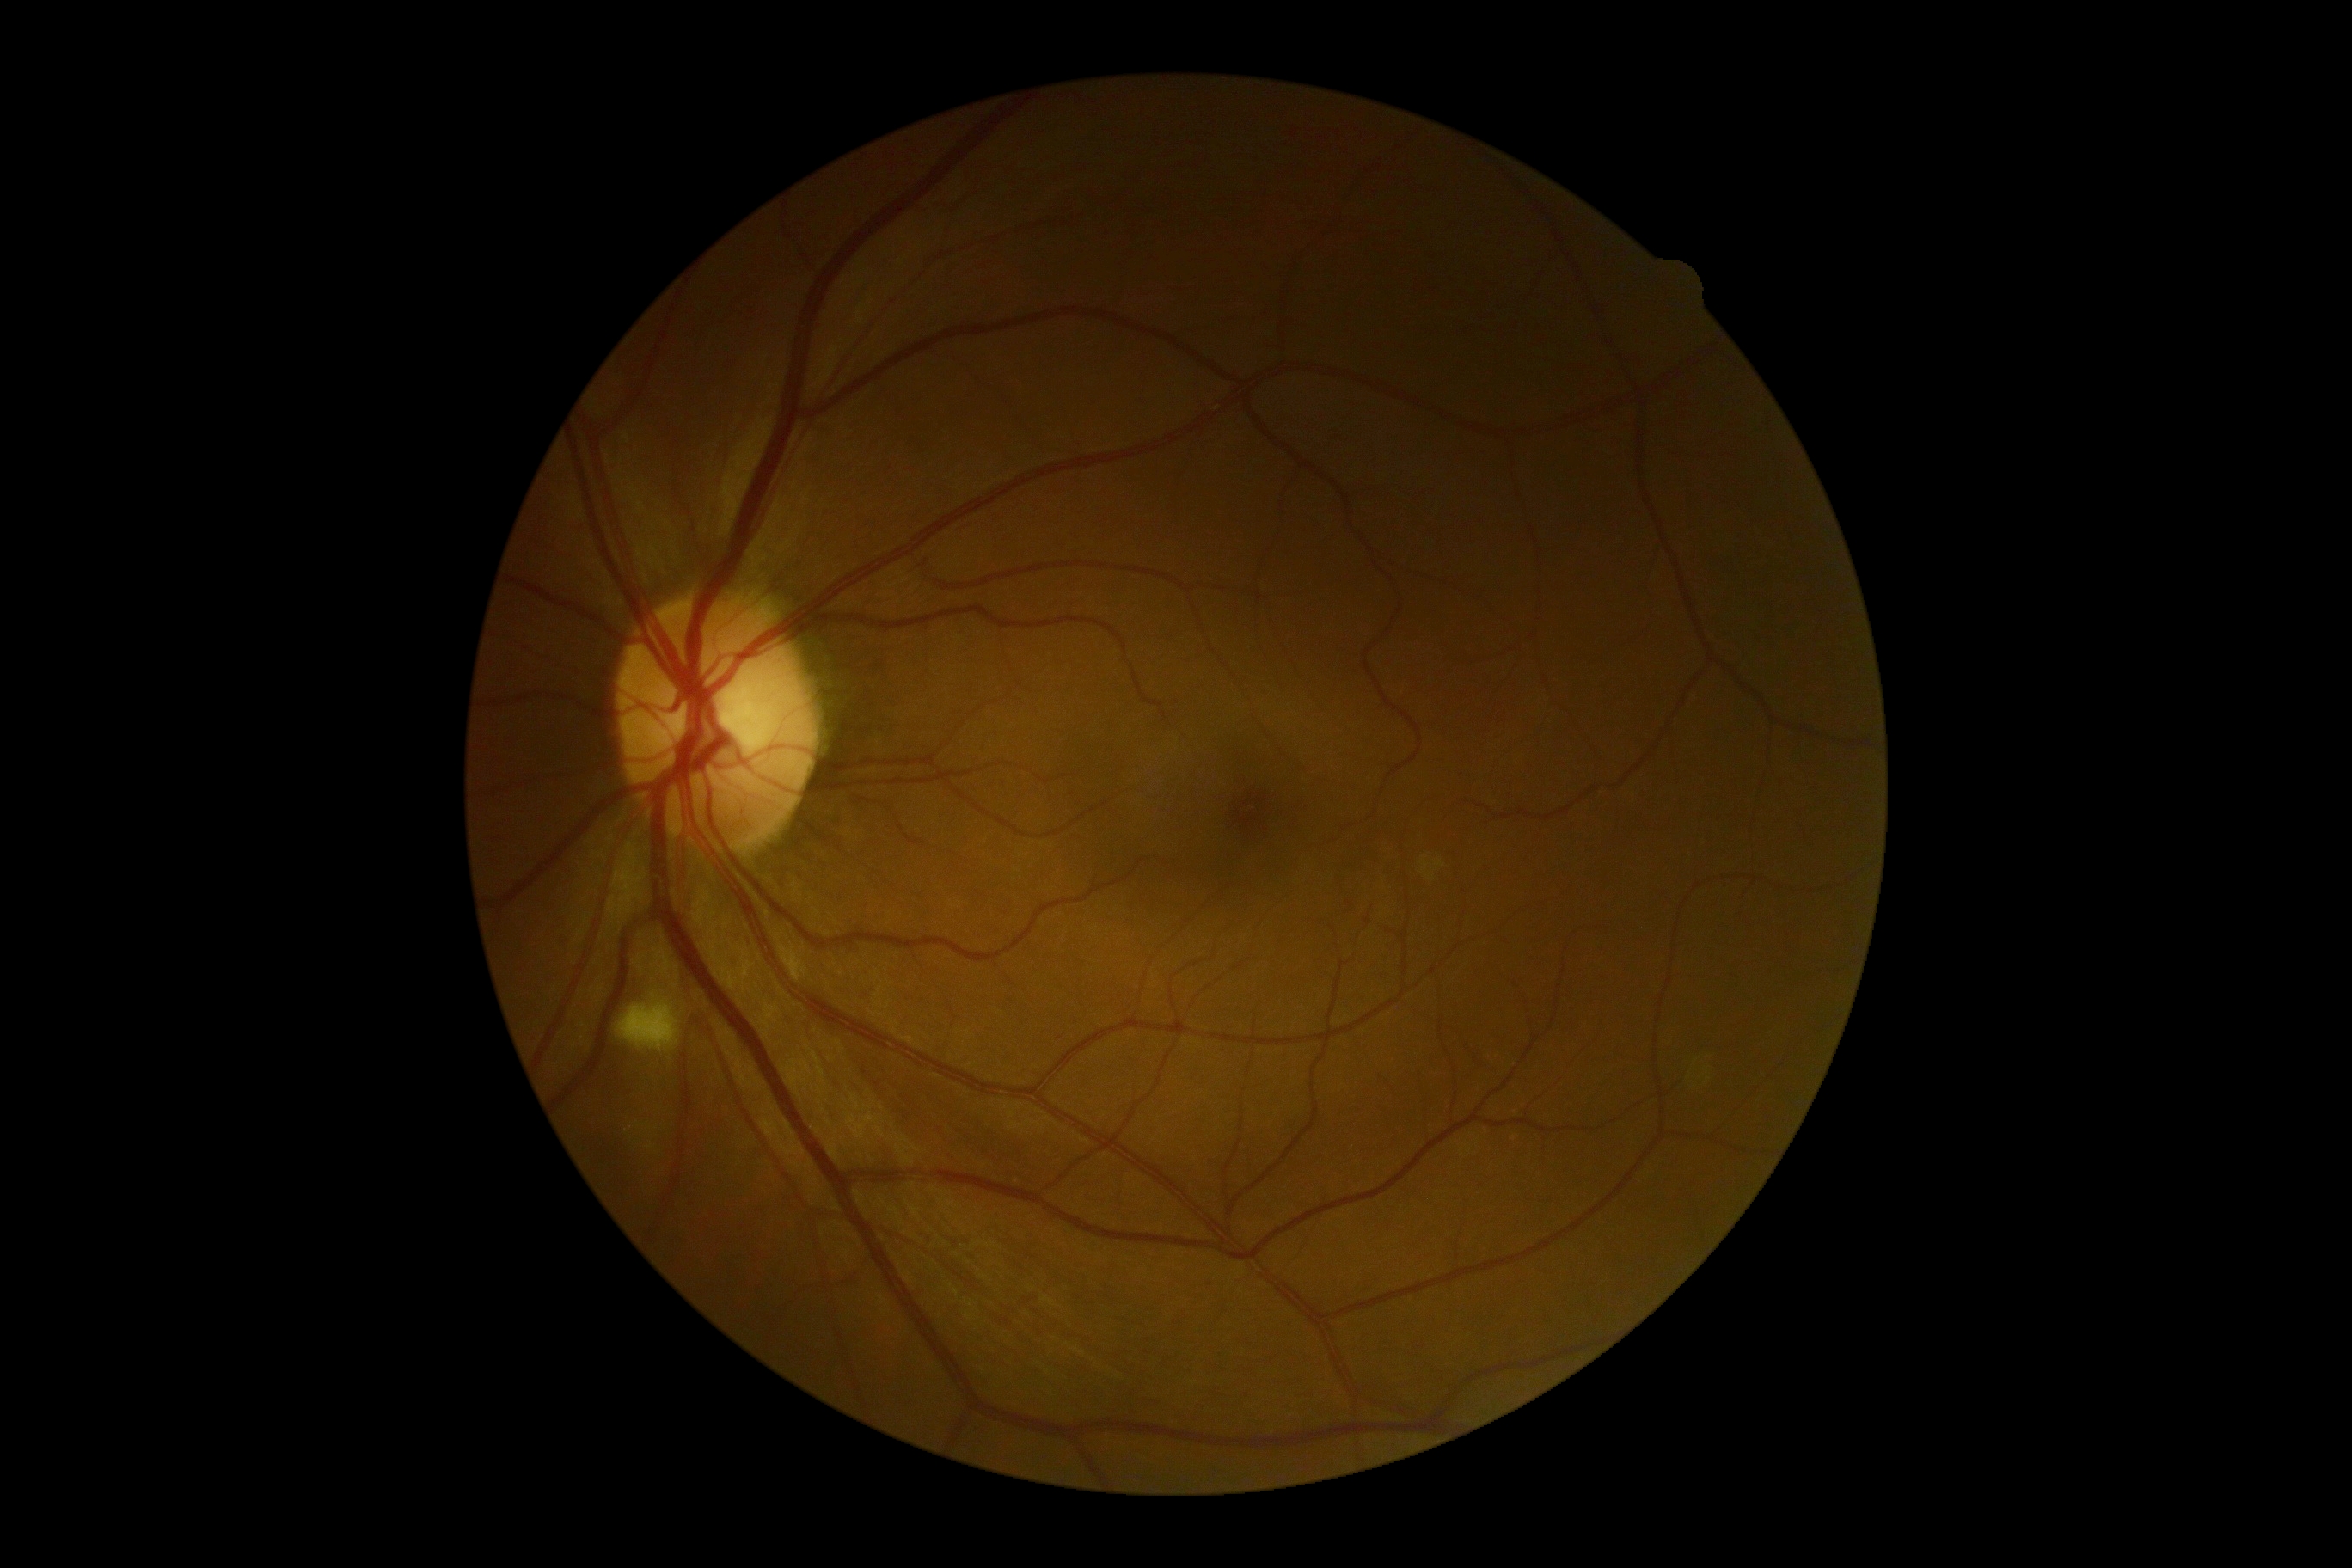
Diabetic retinopathy (DR): 2/4.